2352 by 1568 pixels, fundus photo, 45° FOV.
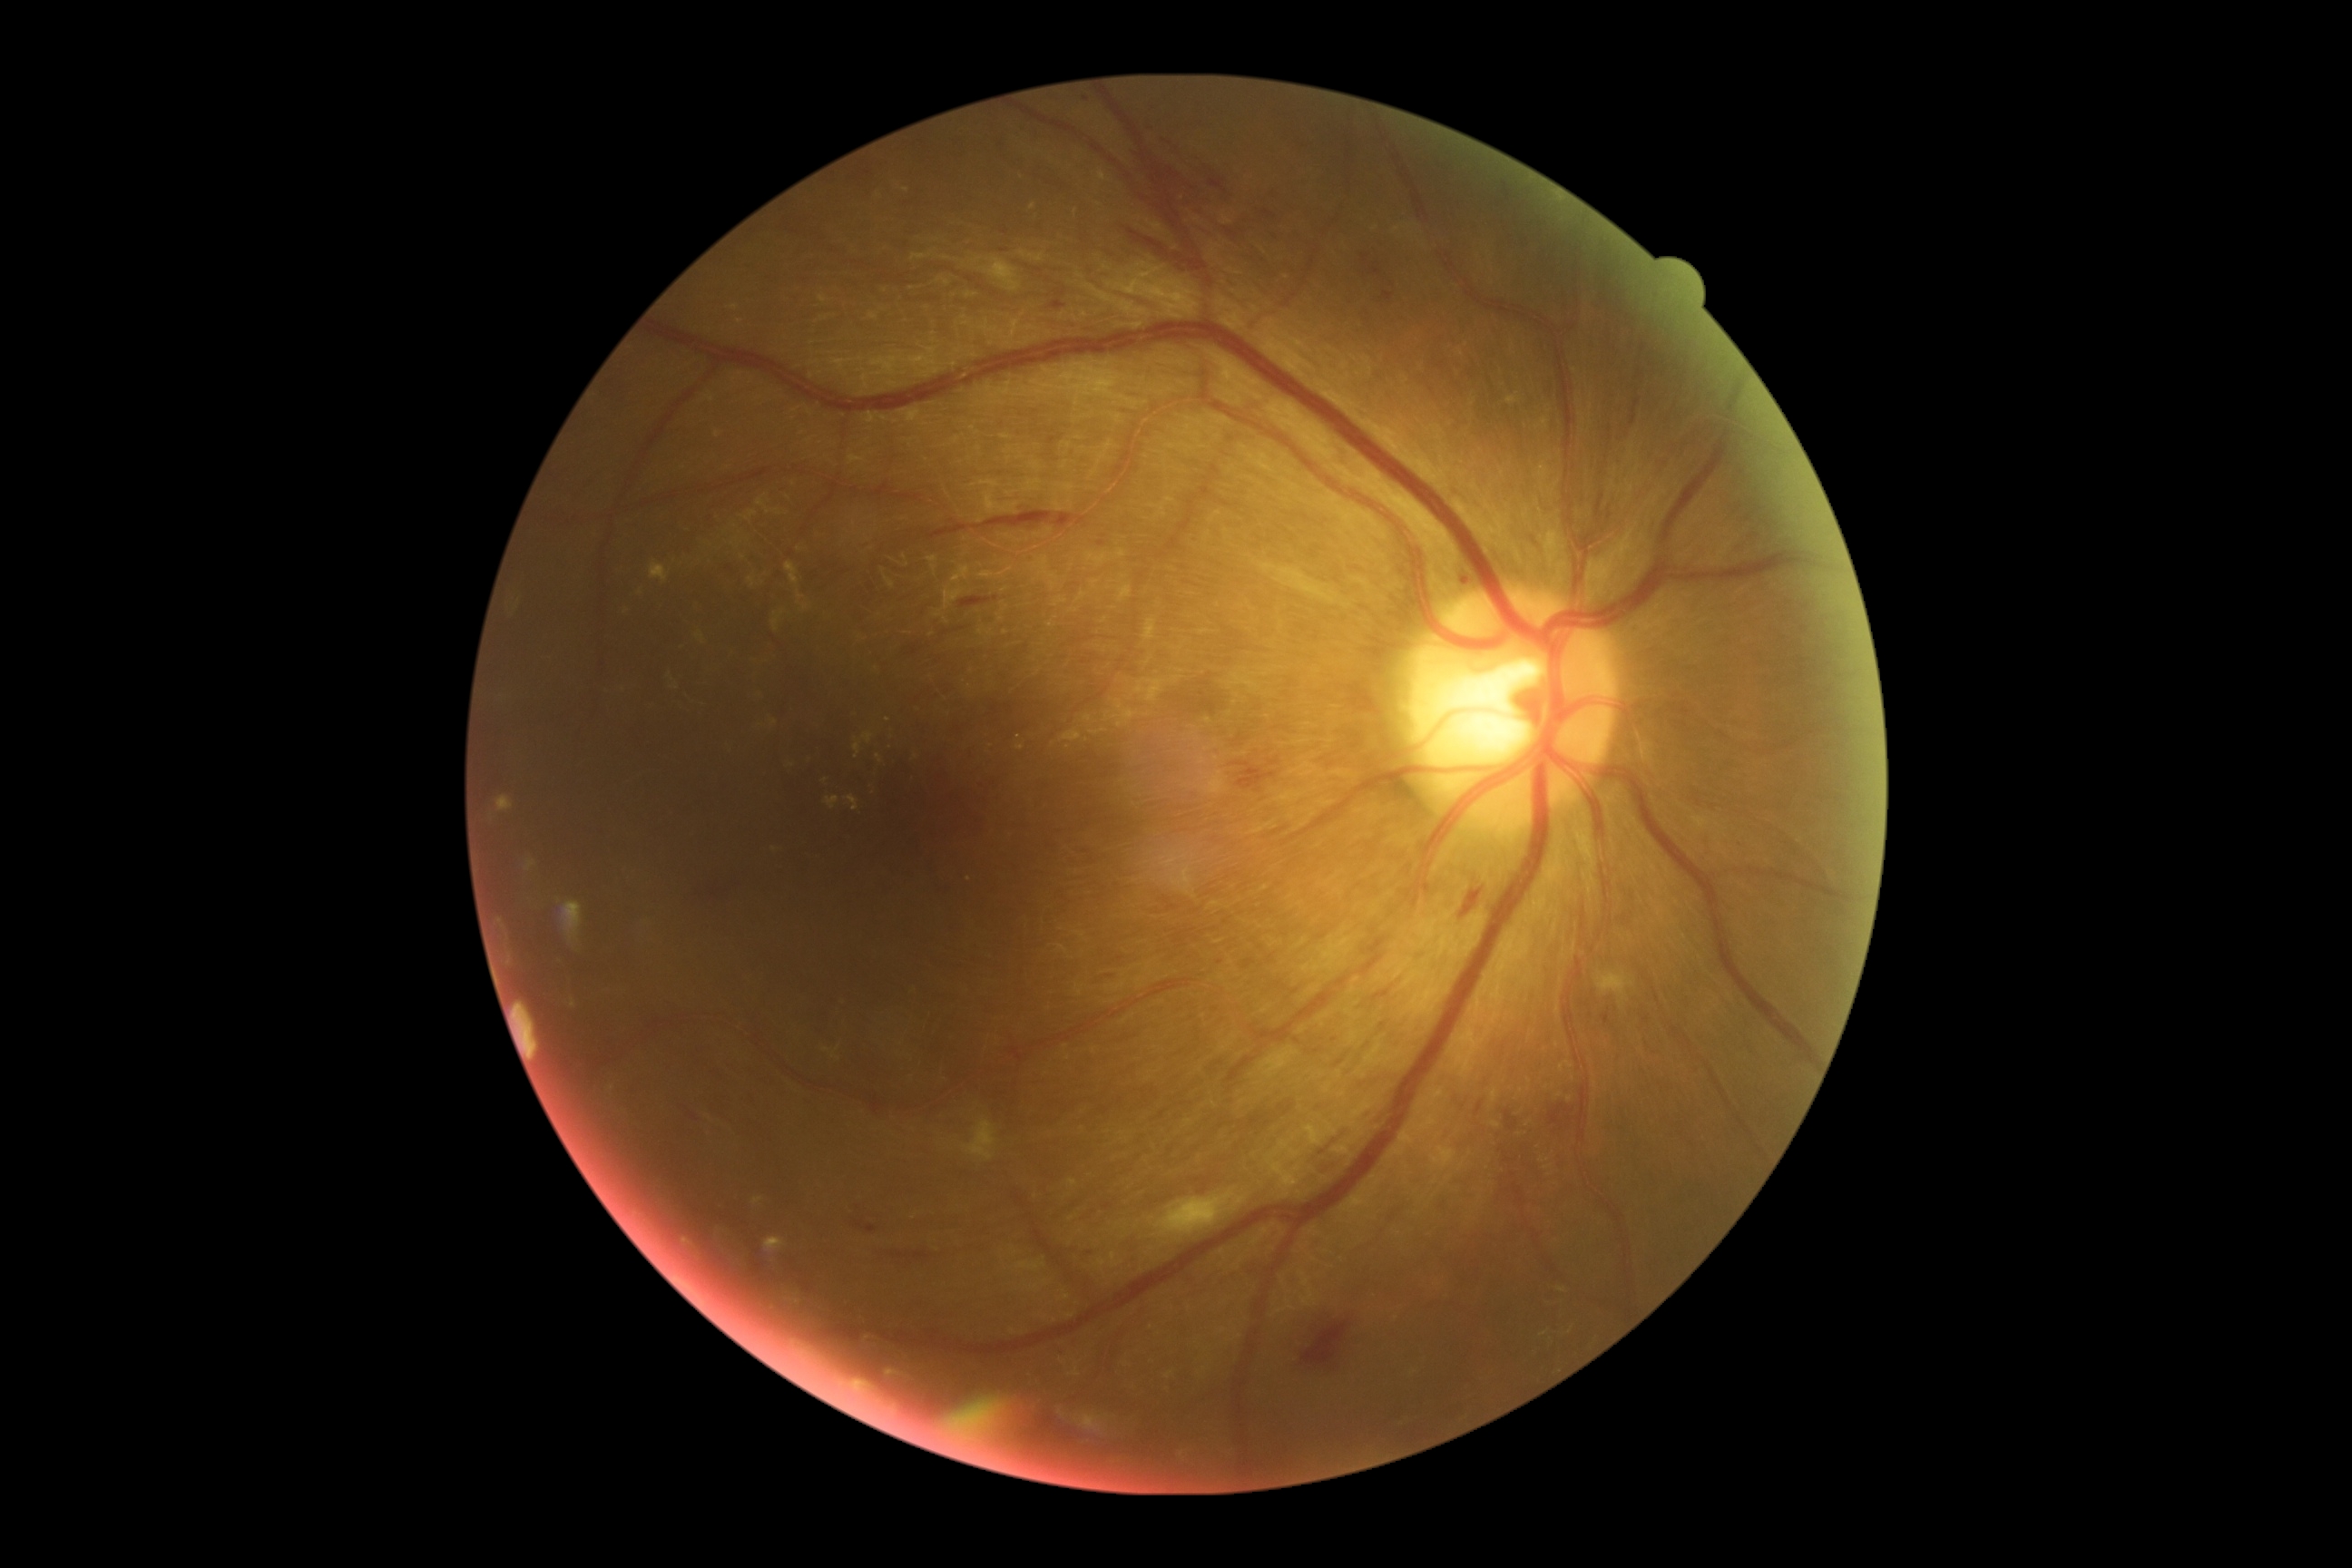

Disease class: non-proliferative diabetic retinopathy. Diabetic retinopathy (DR): moderate NPDR (grade 2) — more than just microaneurysms but less than severe NPDR.